Retinal fundus photograph — 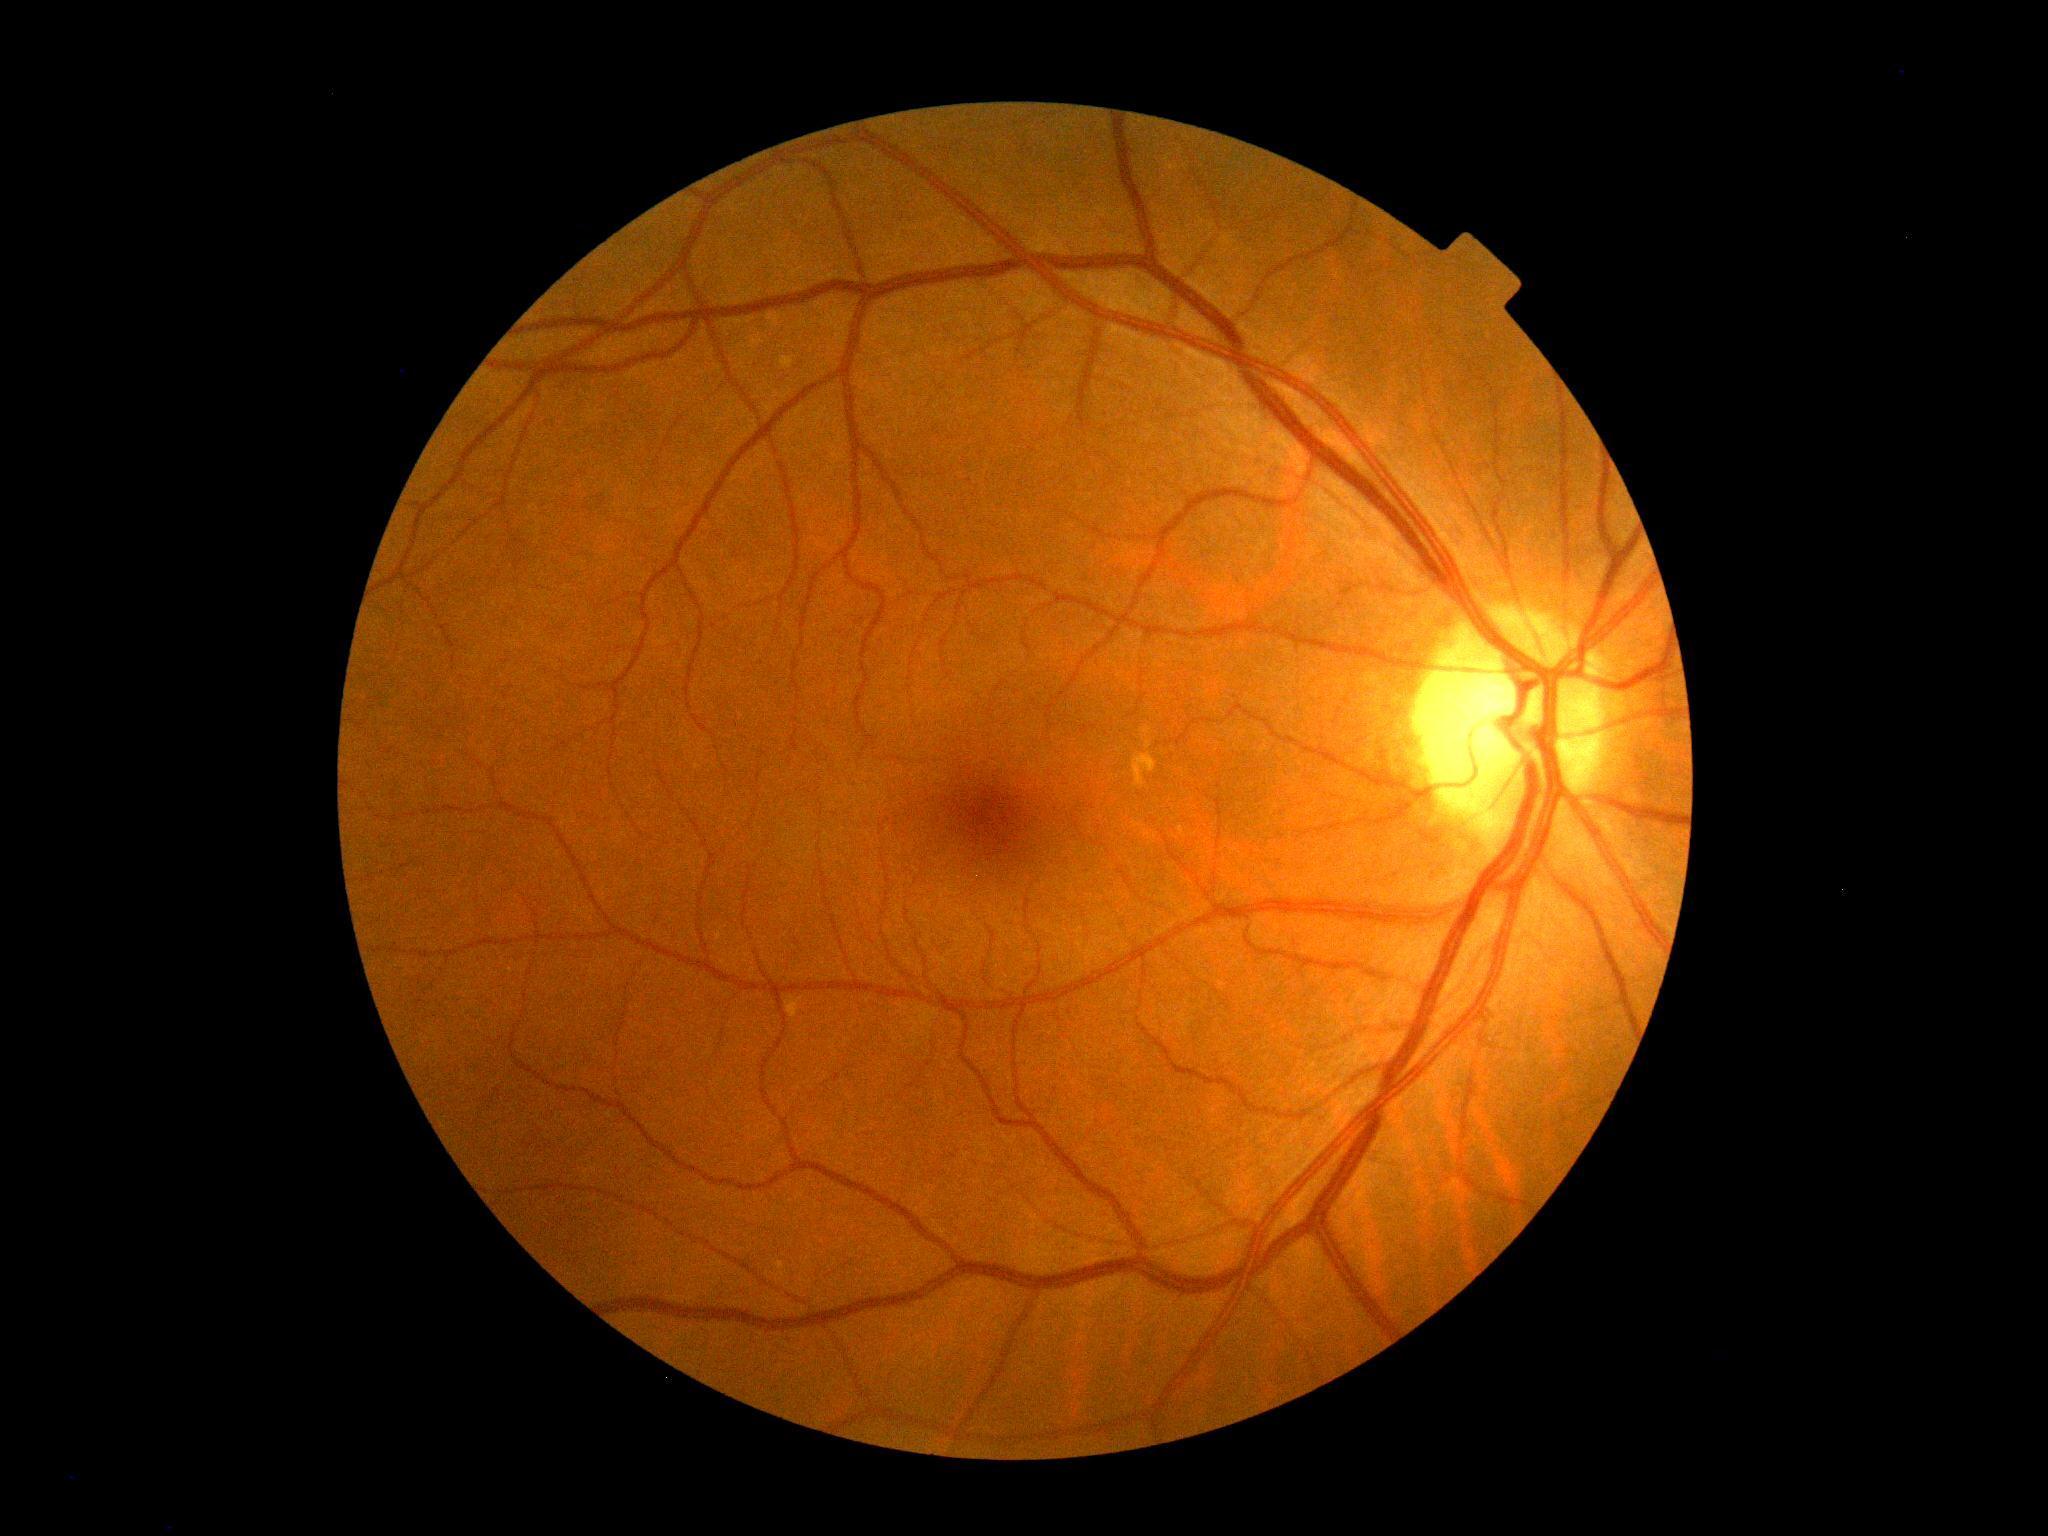

Retinopathy is 0/4 — no visible signs of diabetic retinopathy. No apparent diabetic retinopathy.